2228 by 1652 pixels: 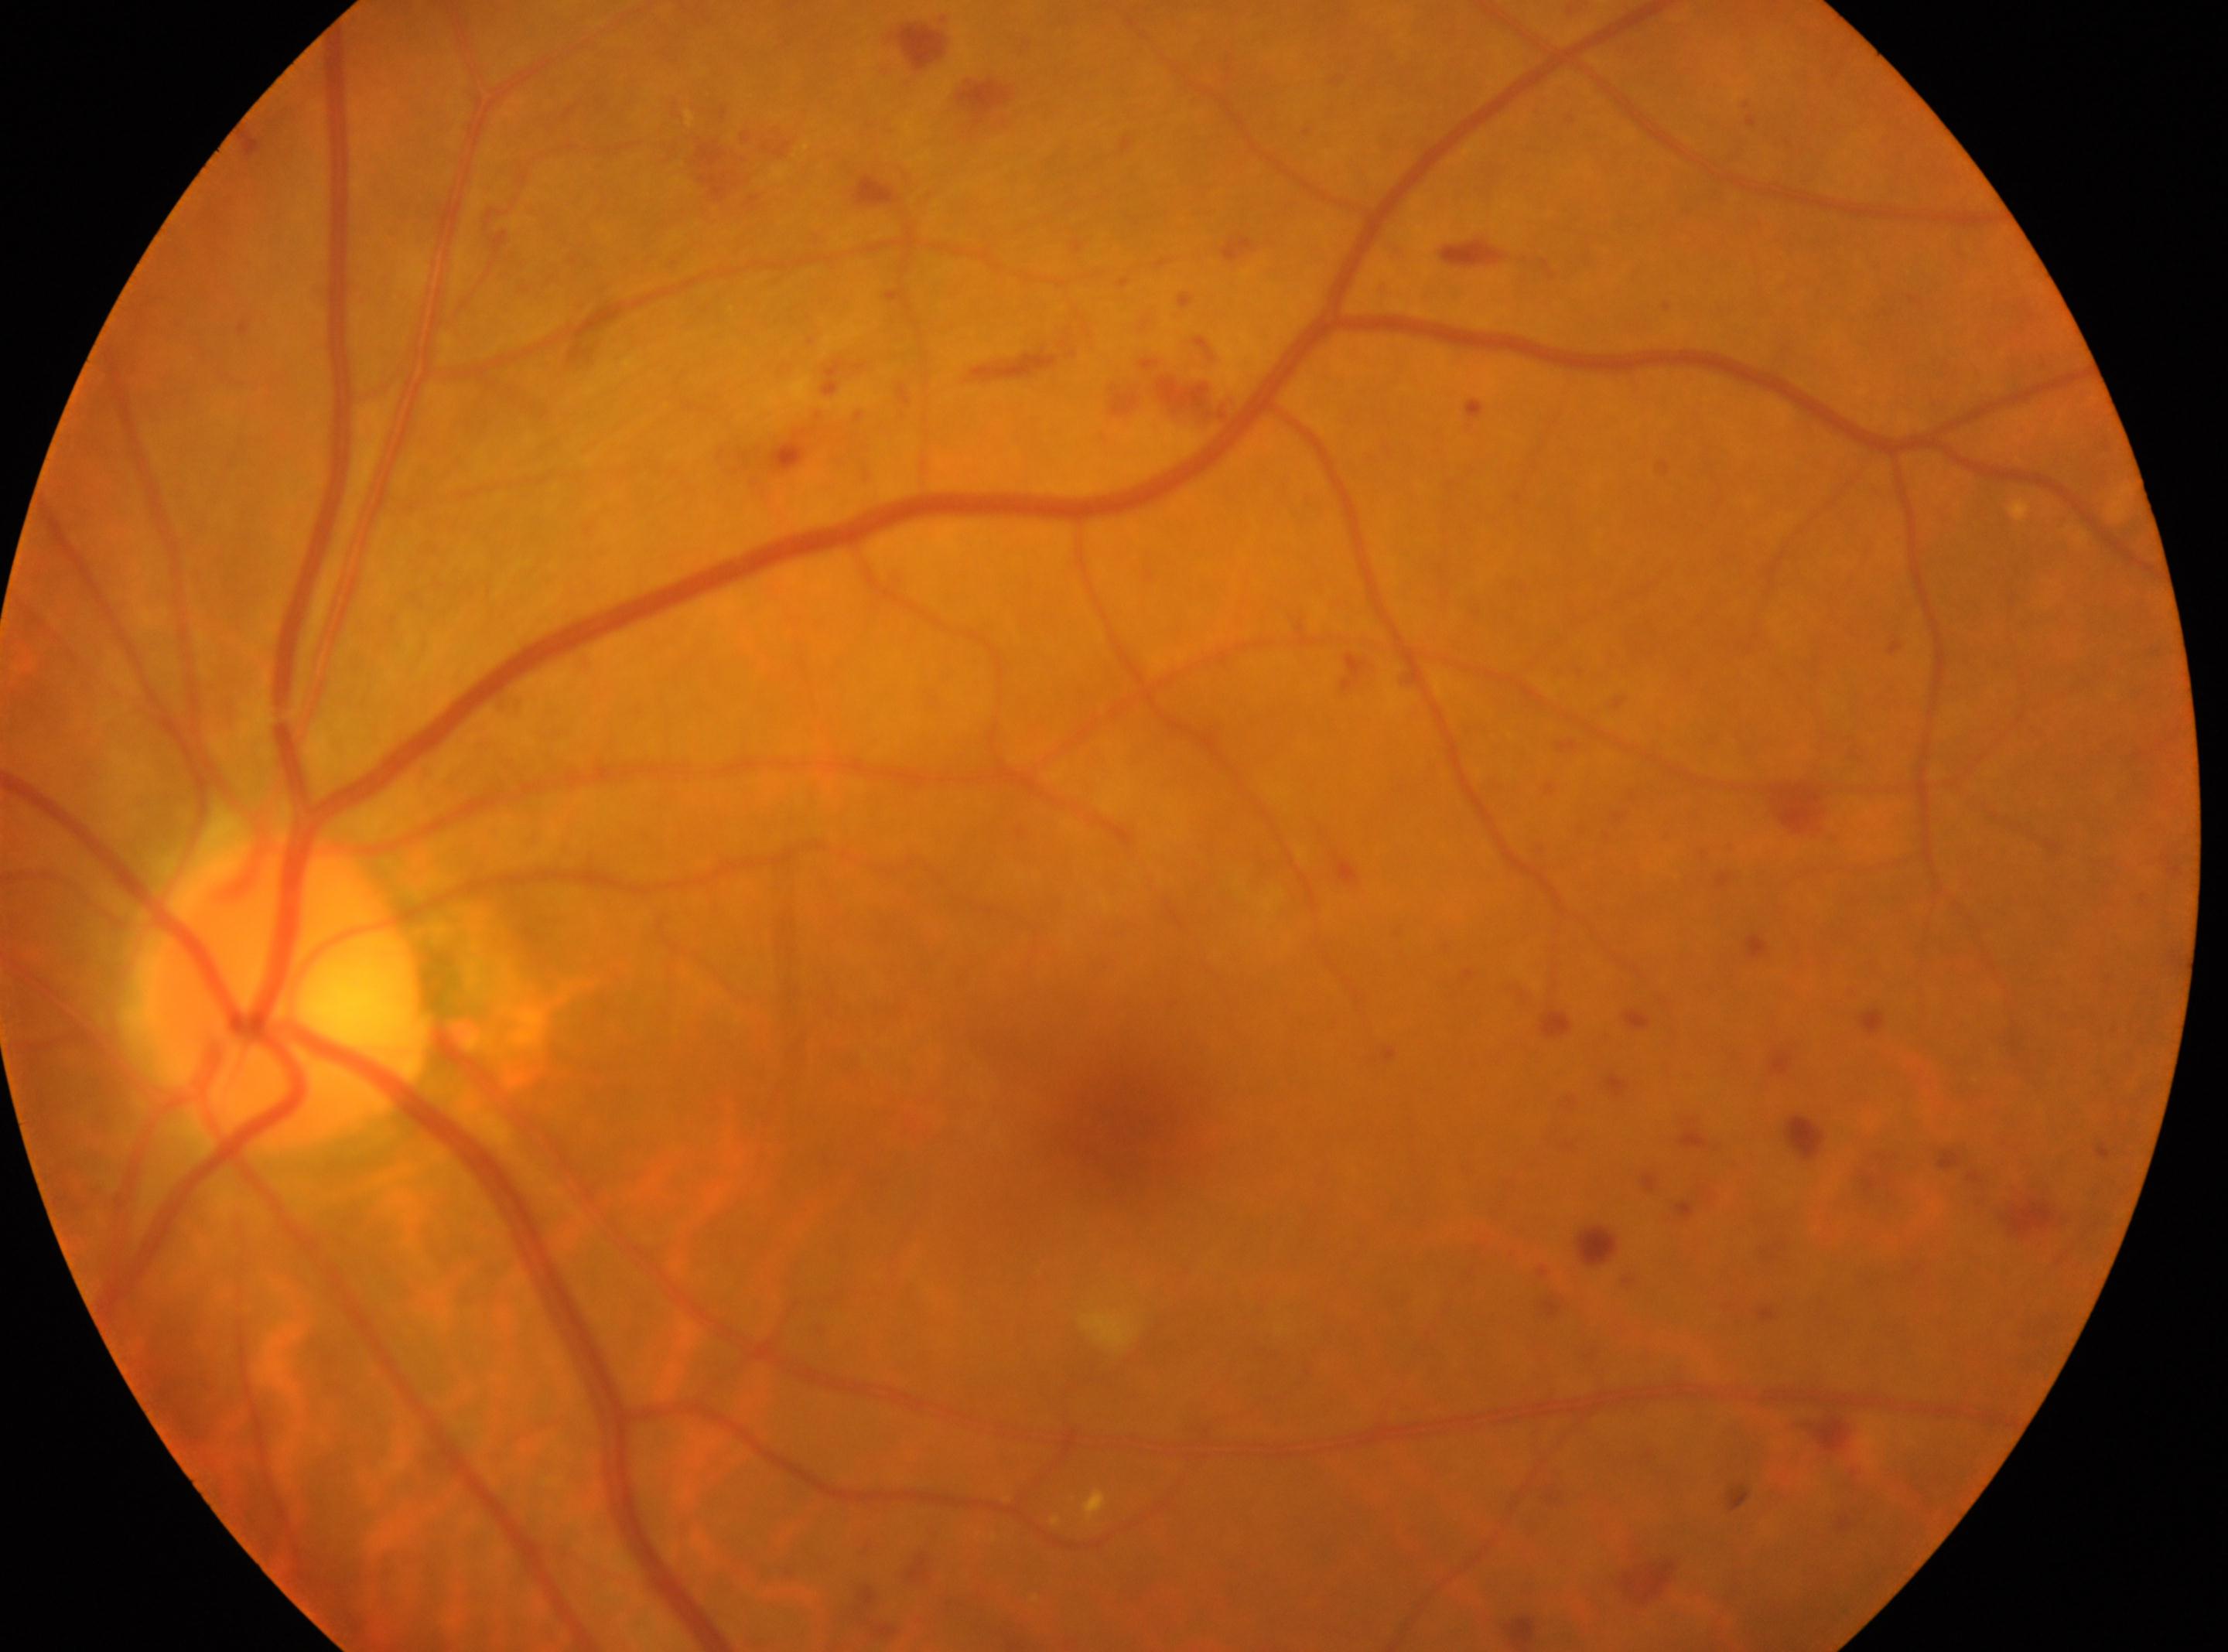
disc center: (285,992); eye: OS; fovea center: (1122,1126); retinopathy grade: 2 (moderate NPDR) — more than just microaneurysms but less than severe NPDR.